45° field of view, modified Davis classification:
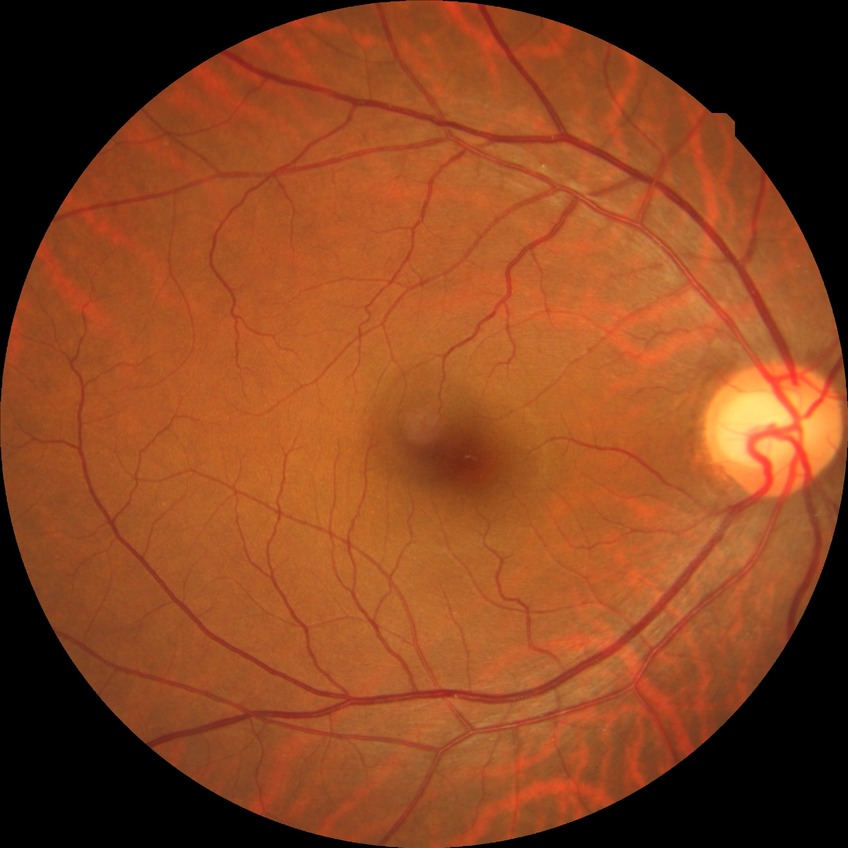

Retinopathy grade is no diabetic retinopathy.